45-degree field of view — 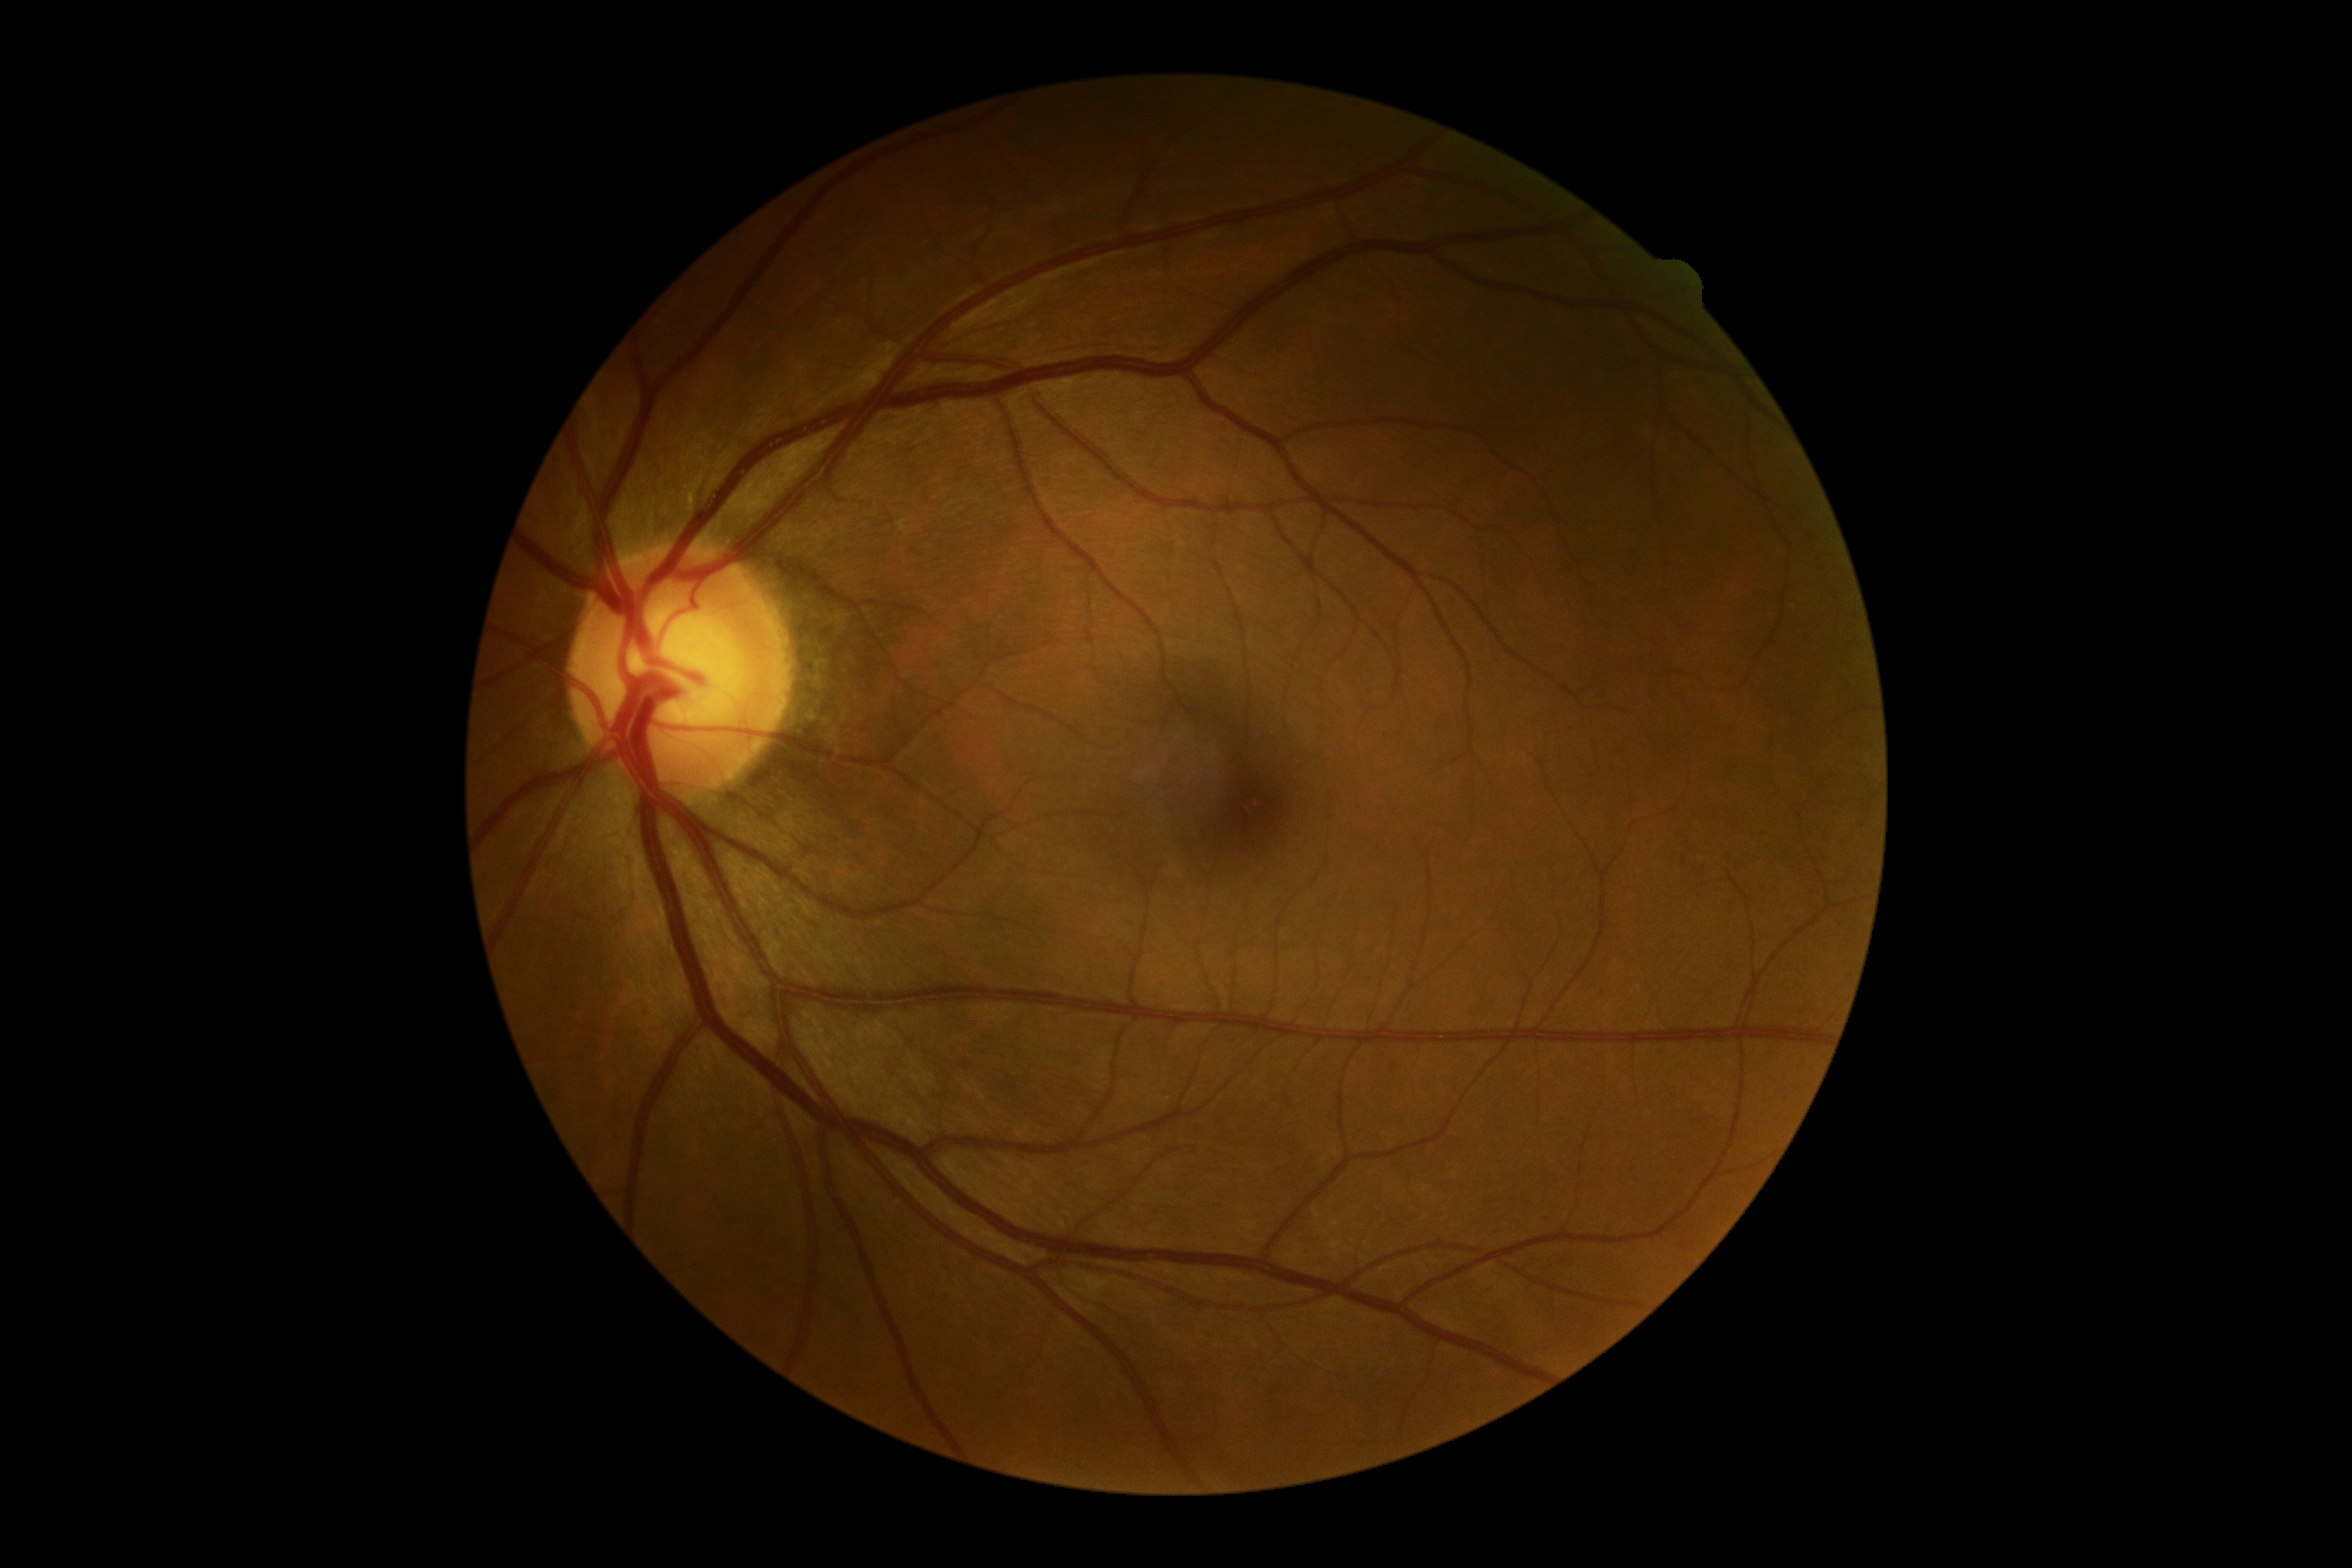
Diabetic retinopathy (DR): grade 0 (no apparent retinopathy).